Davis DR grading
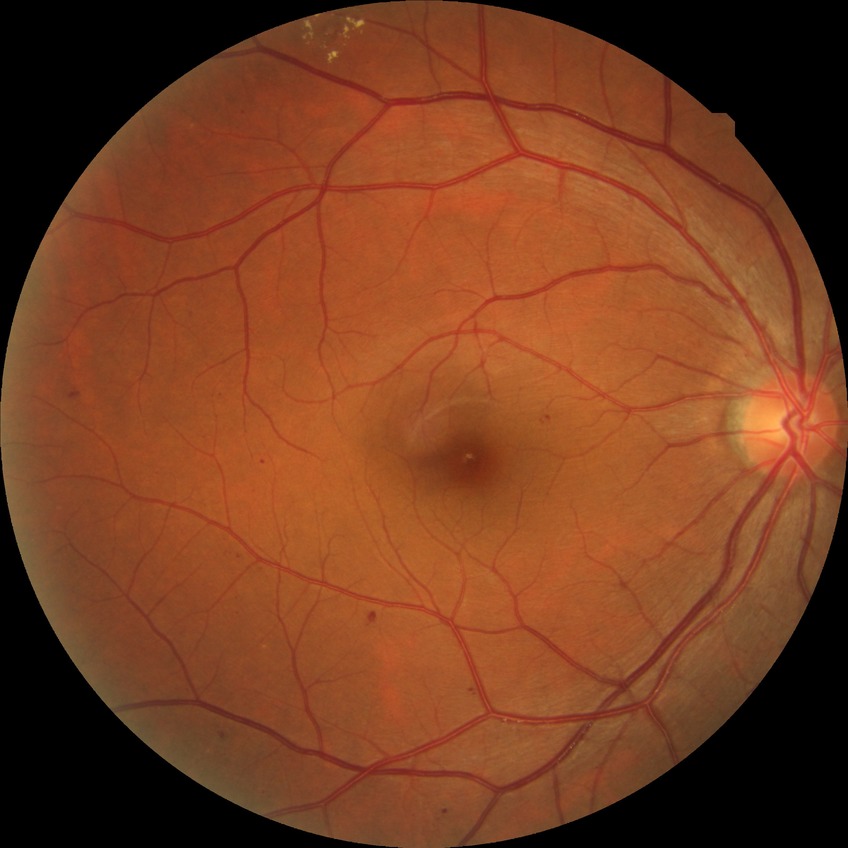 Diabetic retinopathy (DR): simple diabetic retinopathy (SDR).